2352x1568px · 45° FOV · color fundus photograph
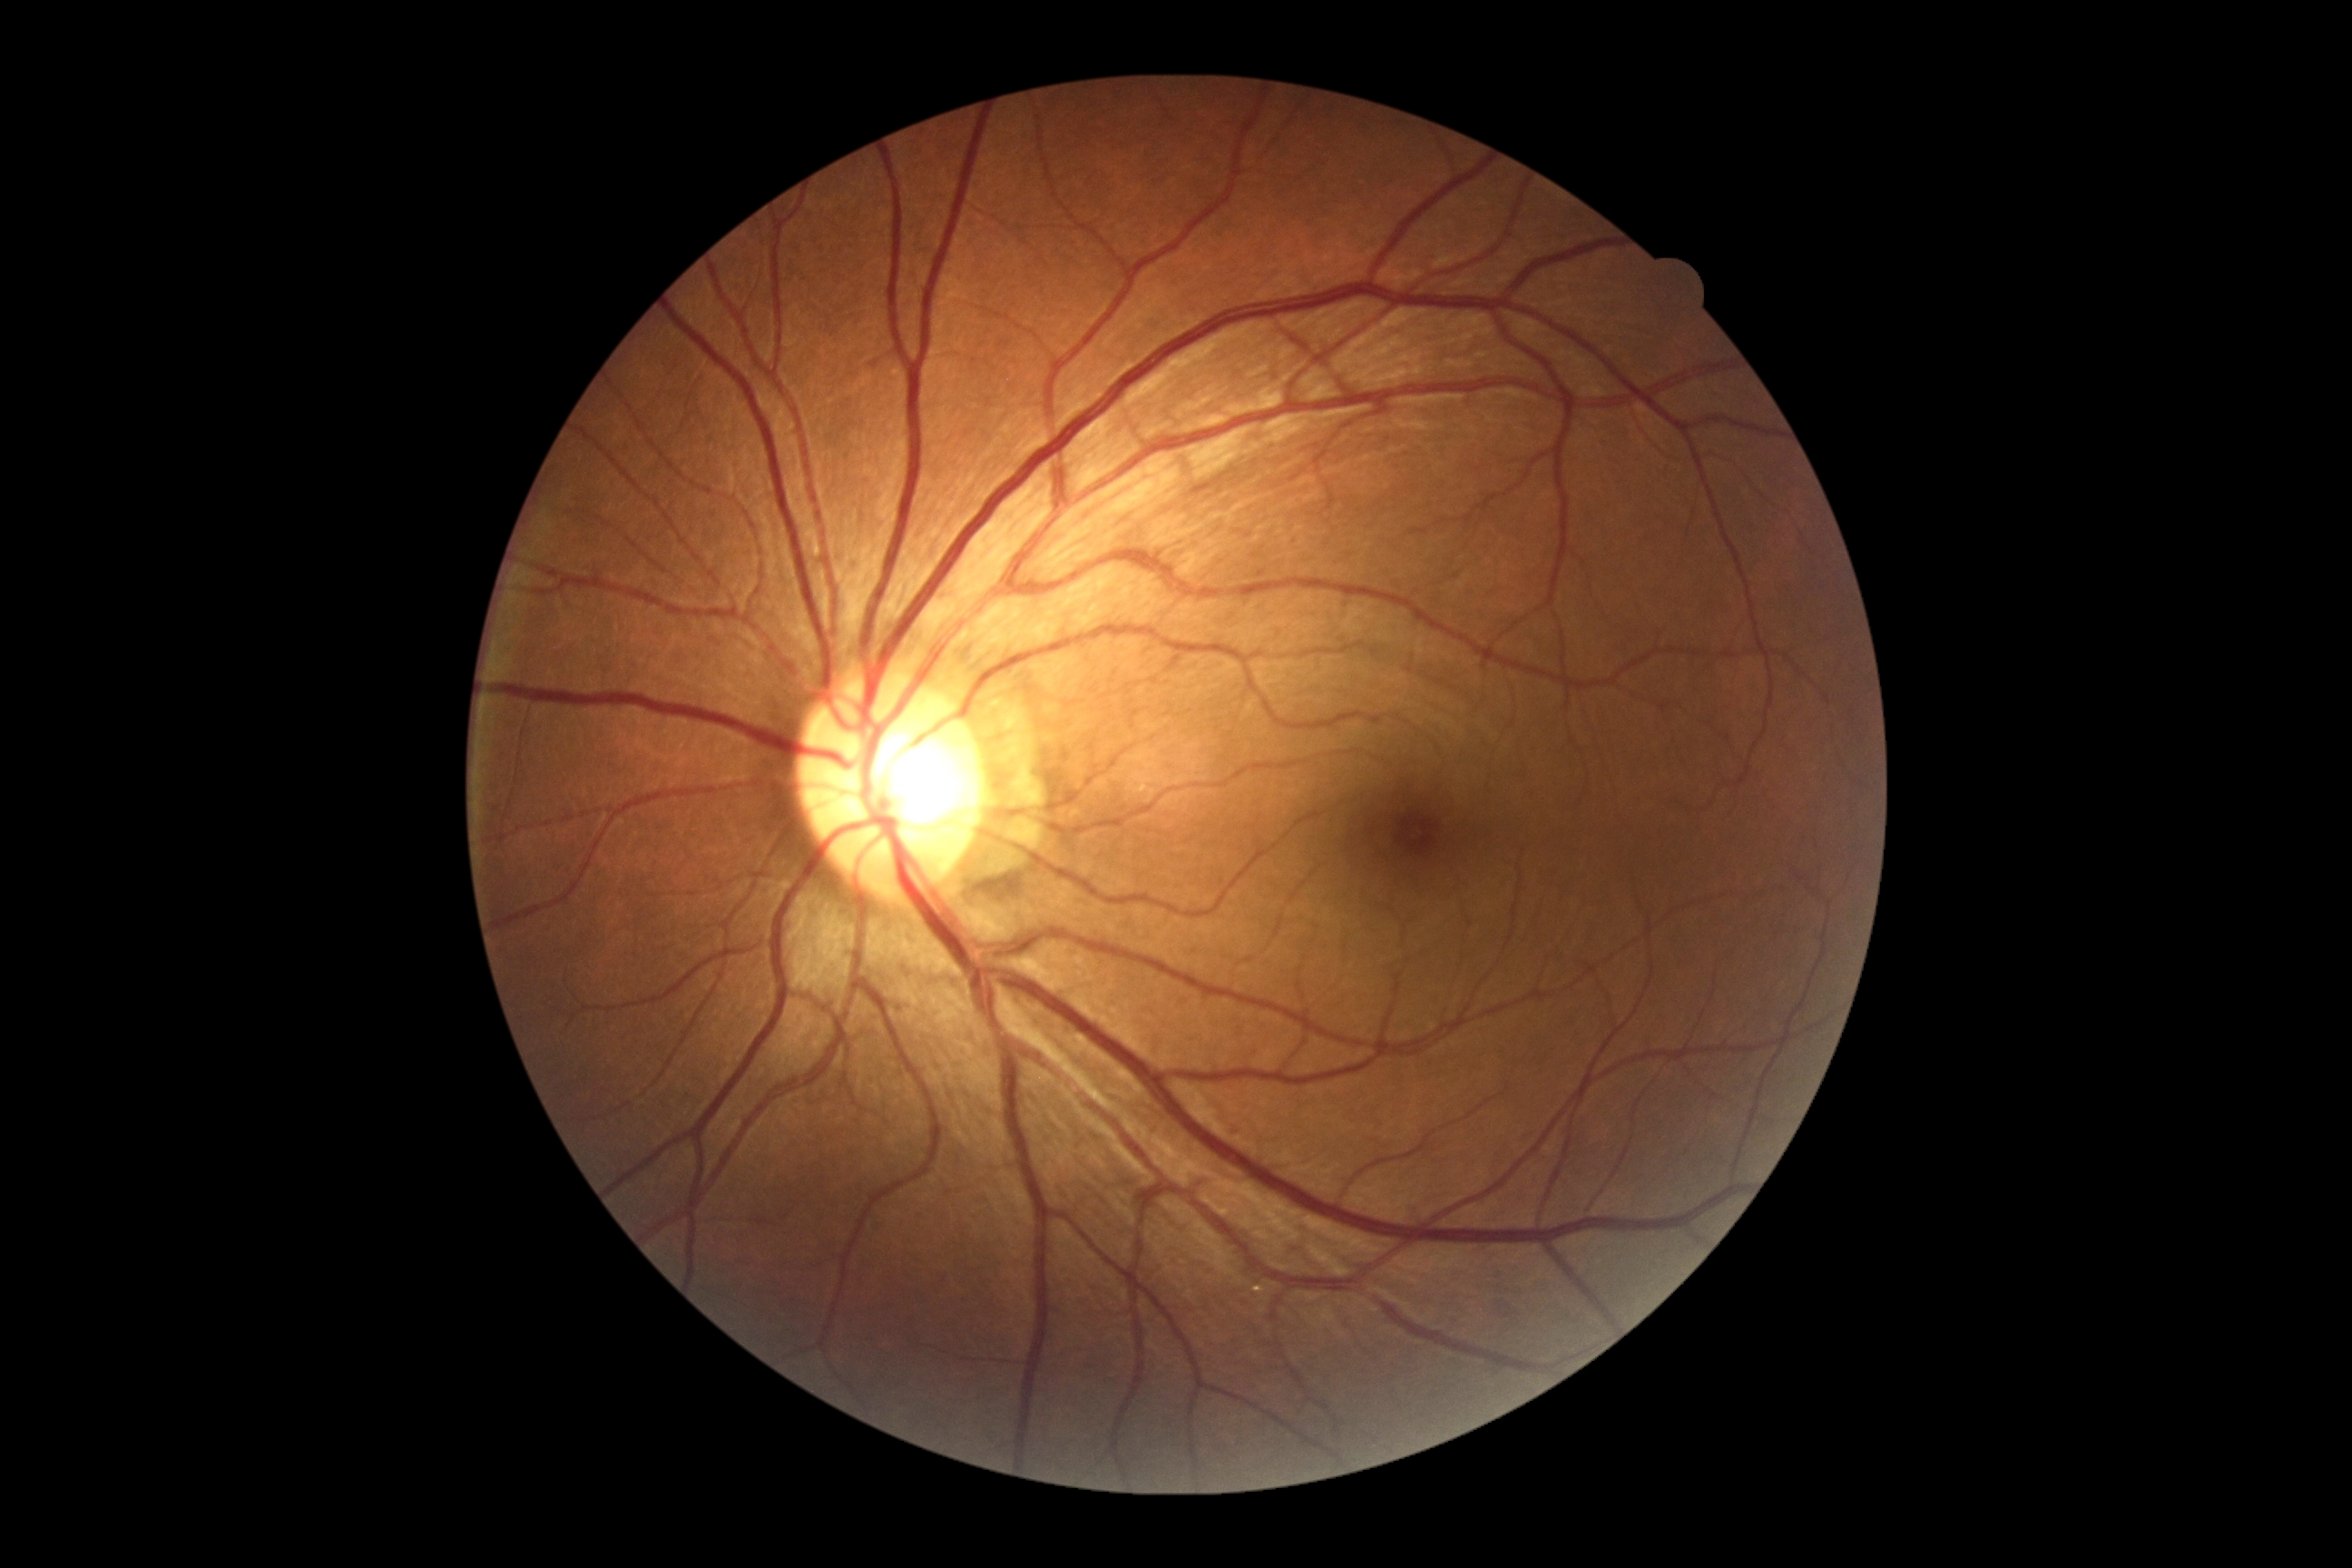

No diabetic retinal disease findings.
DR grade: no apparent retinopathy (0).